2048x1536px; 45-degree field of view
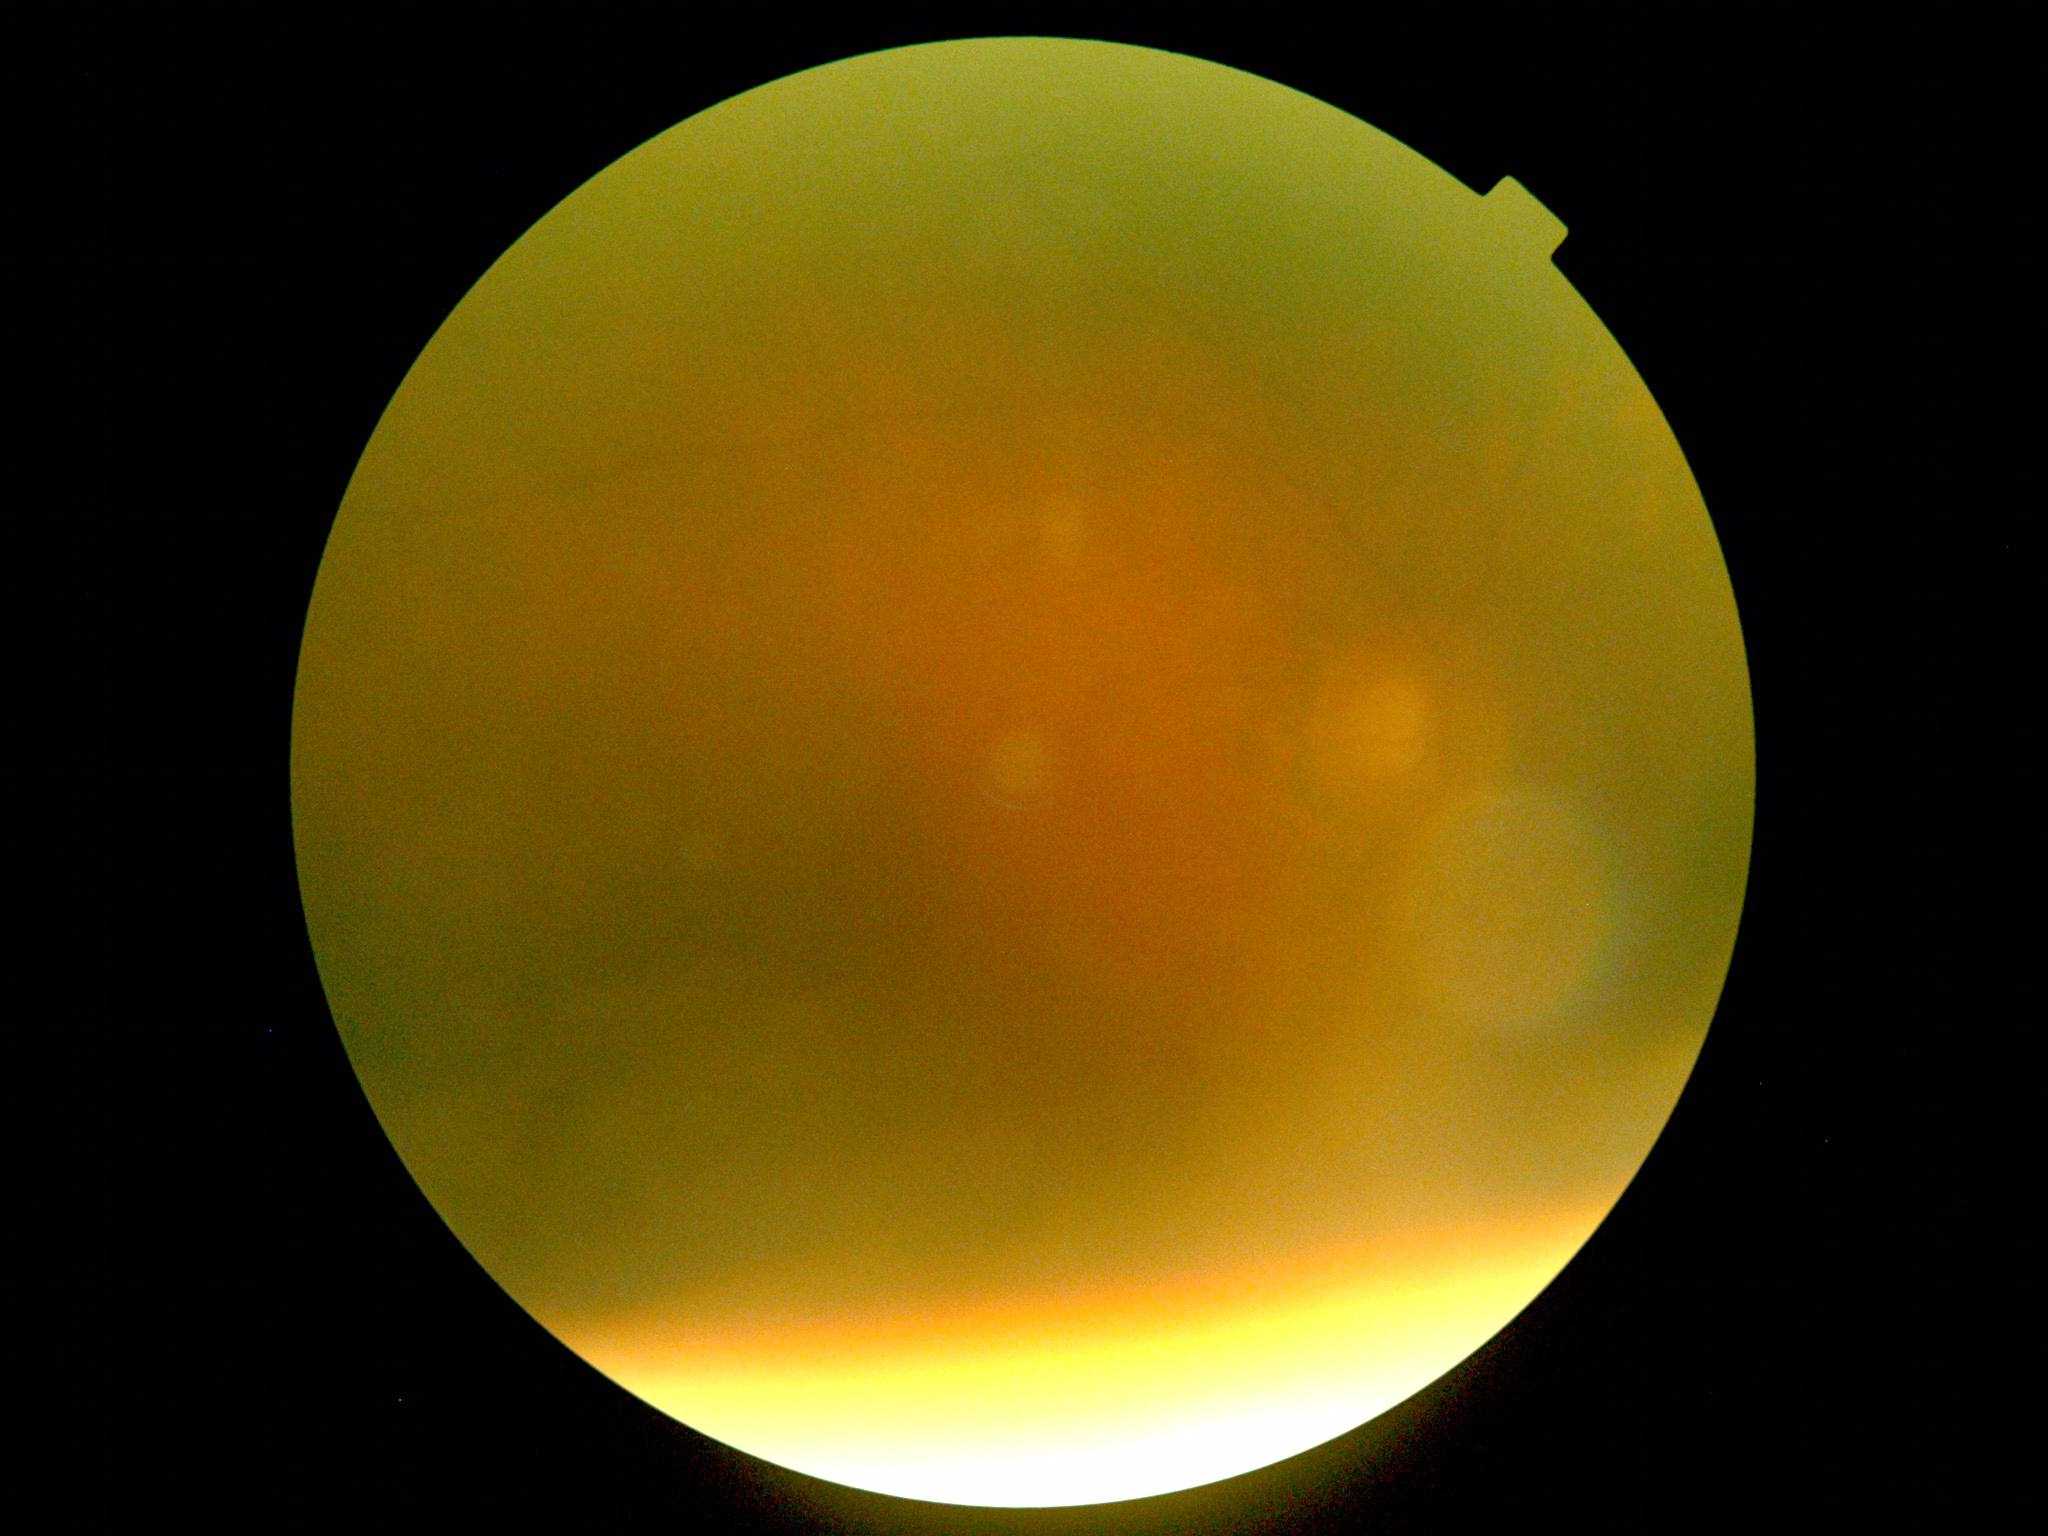

DR grade is ungradable.